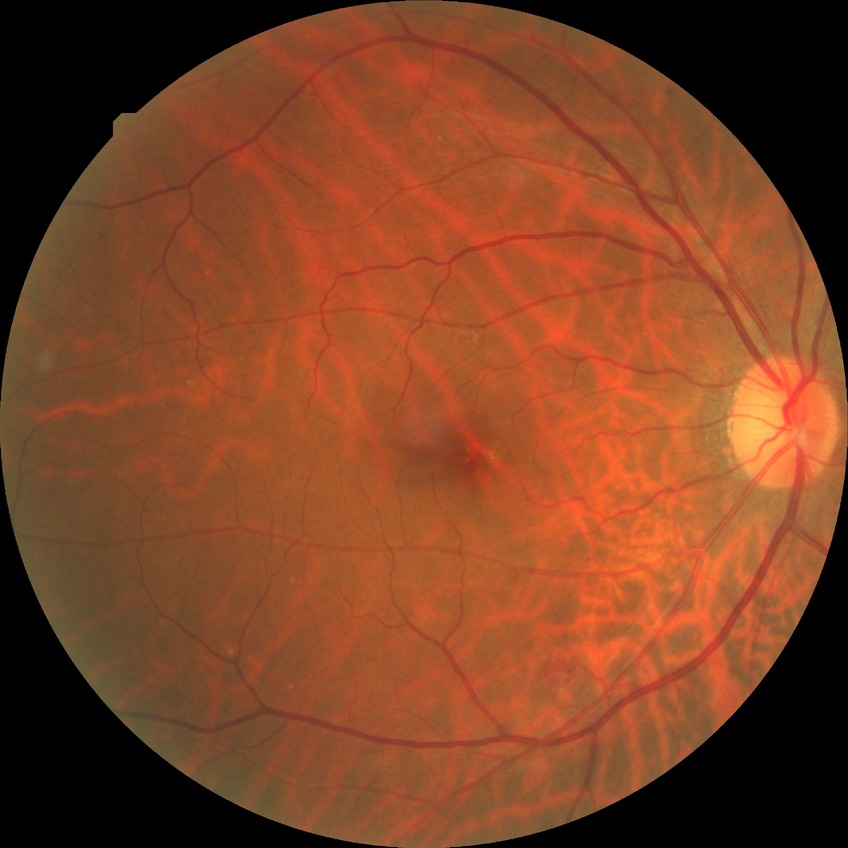
Diabetic retinopathy (DR) is SDR (simple diabetic retinopathy).